Wide-field fundus photograph of an infant; captured with the Clarity RetCam 3 (130° field of view): 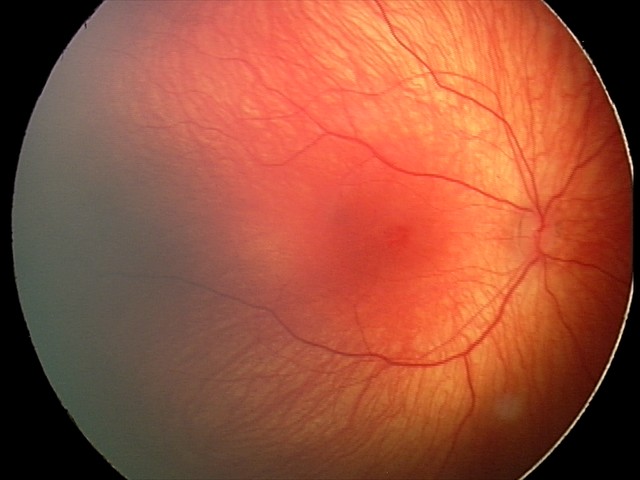 Q: What was the screening finding?
A: retinal hemorrhages